NIDEK AFC-230:
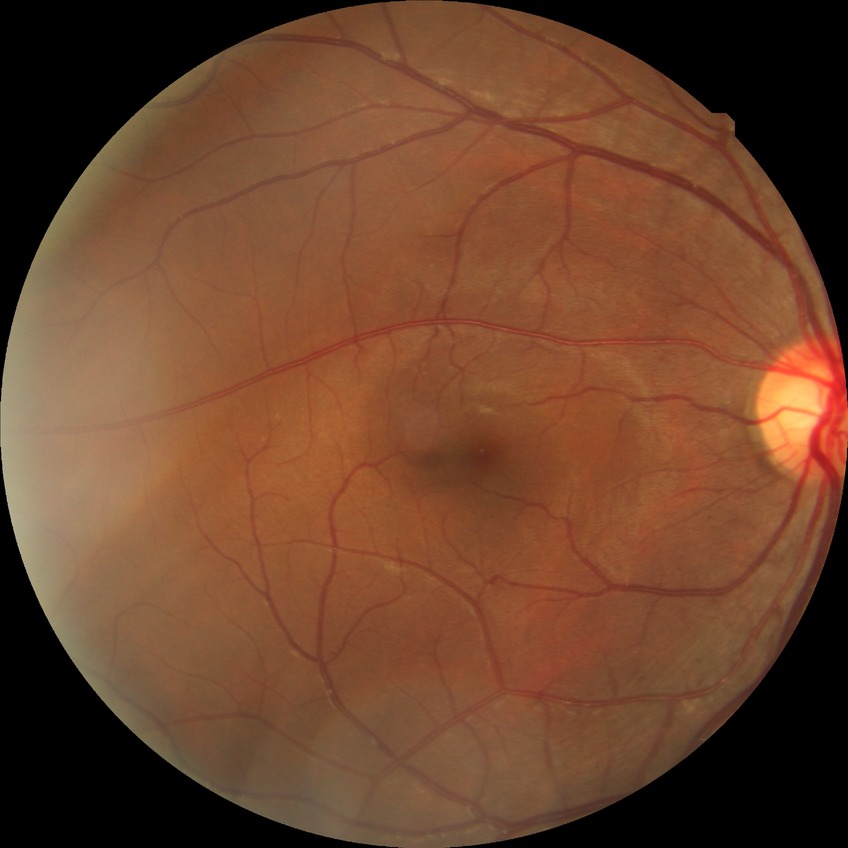
Findings:
– retinopathy grade: no diabetic retinopathy